45 degree fundus photograph, diabetic retinopathy graded by the modified Davis classification, image size 848x848.
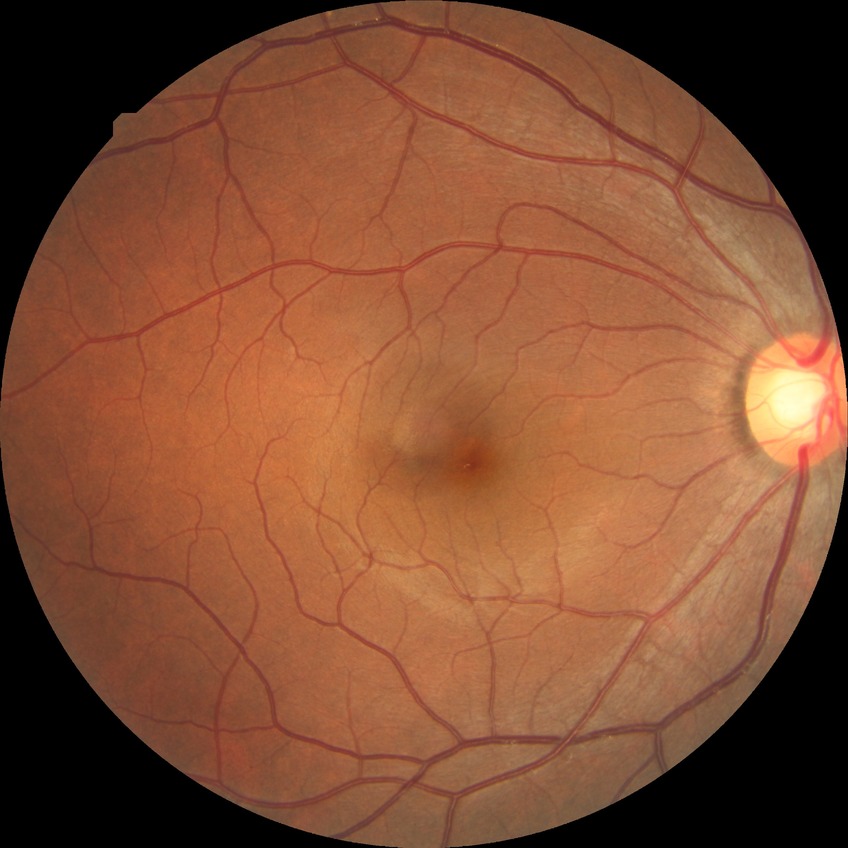 Diabetic retinopathy (DR): NDR (no diabetic retinopathy).